640 x 480 pixels; 130° field of view (Clarity RetCam 3); wide-field fundus photograph of an infant.
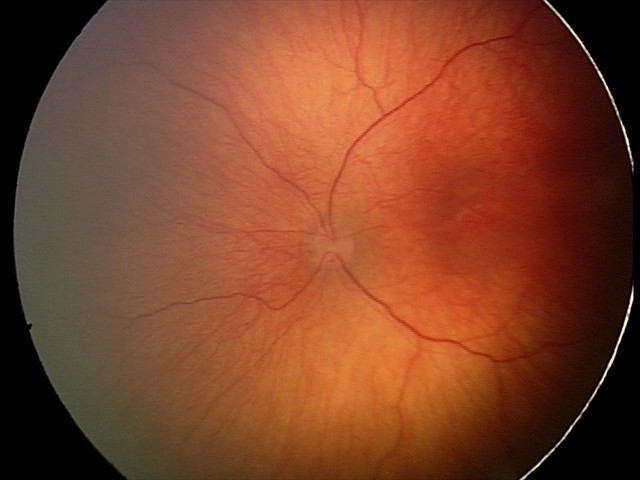 No plus disease. Examination diagnosed as status post retinopathy of prematurity (ROP).